848x848
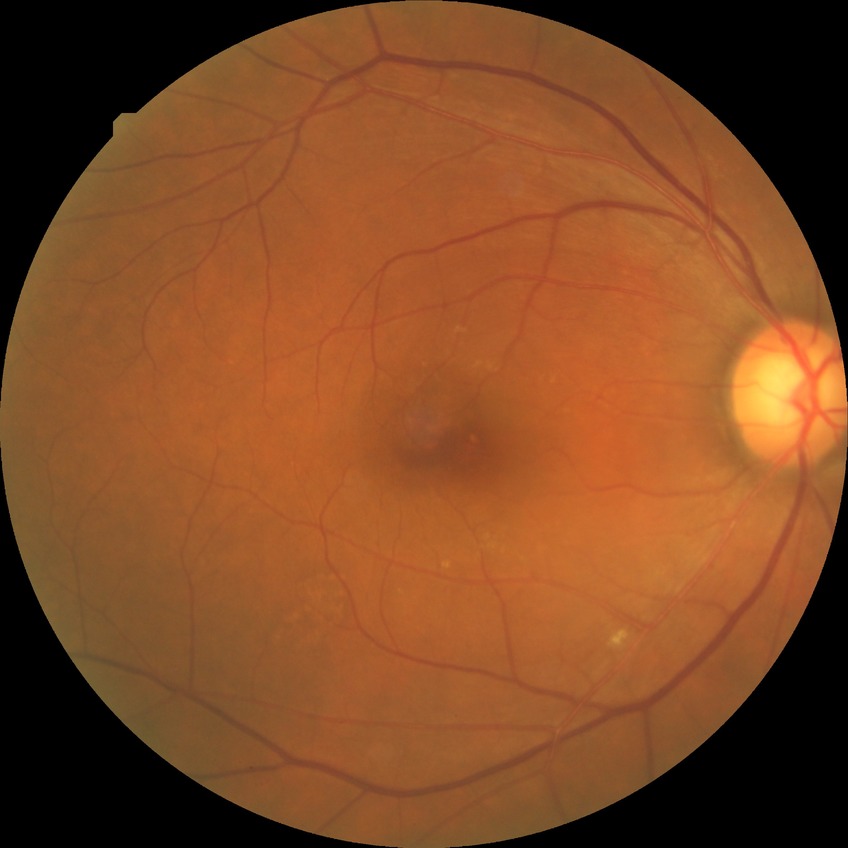

Annotations:
– diabetic retinopathy (DR): NDR (no diabetic retinopathy)